Ultra-widefield (UWF) fundus image.
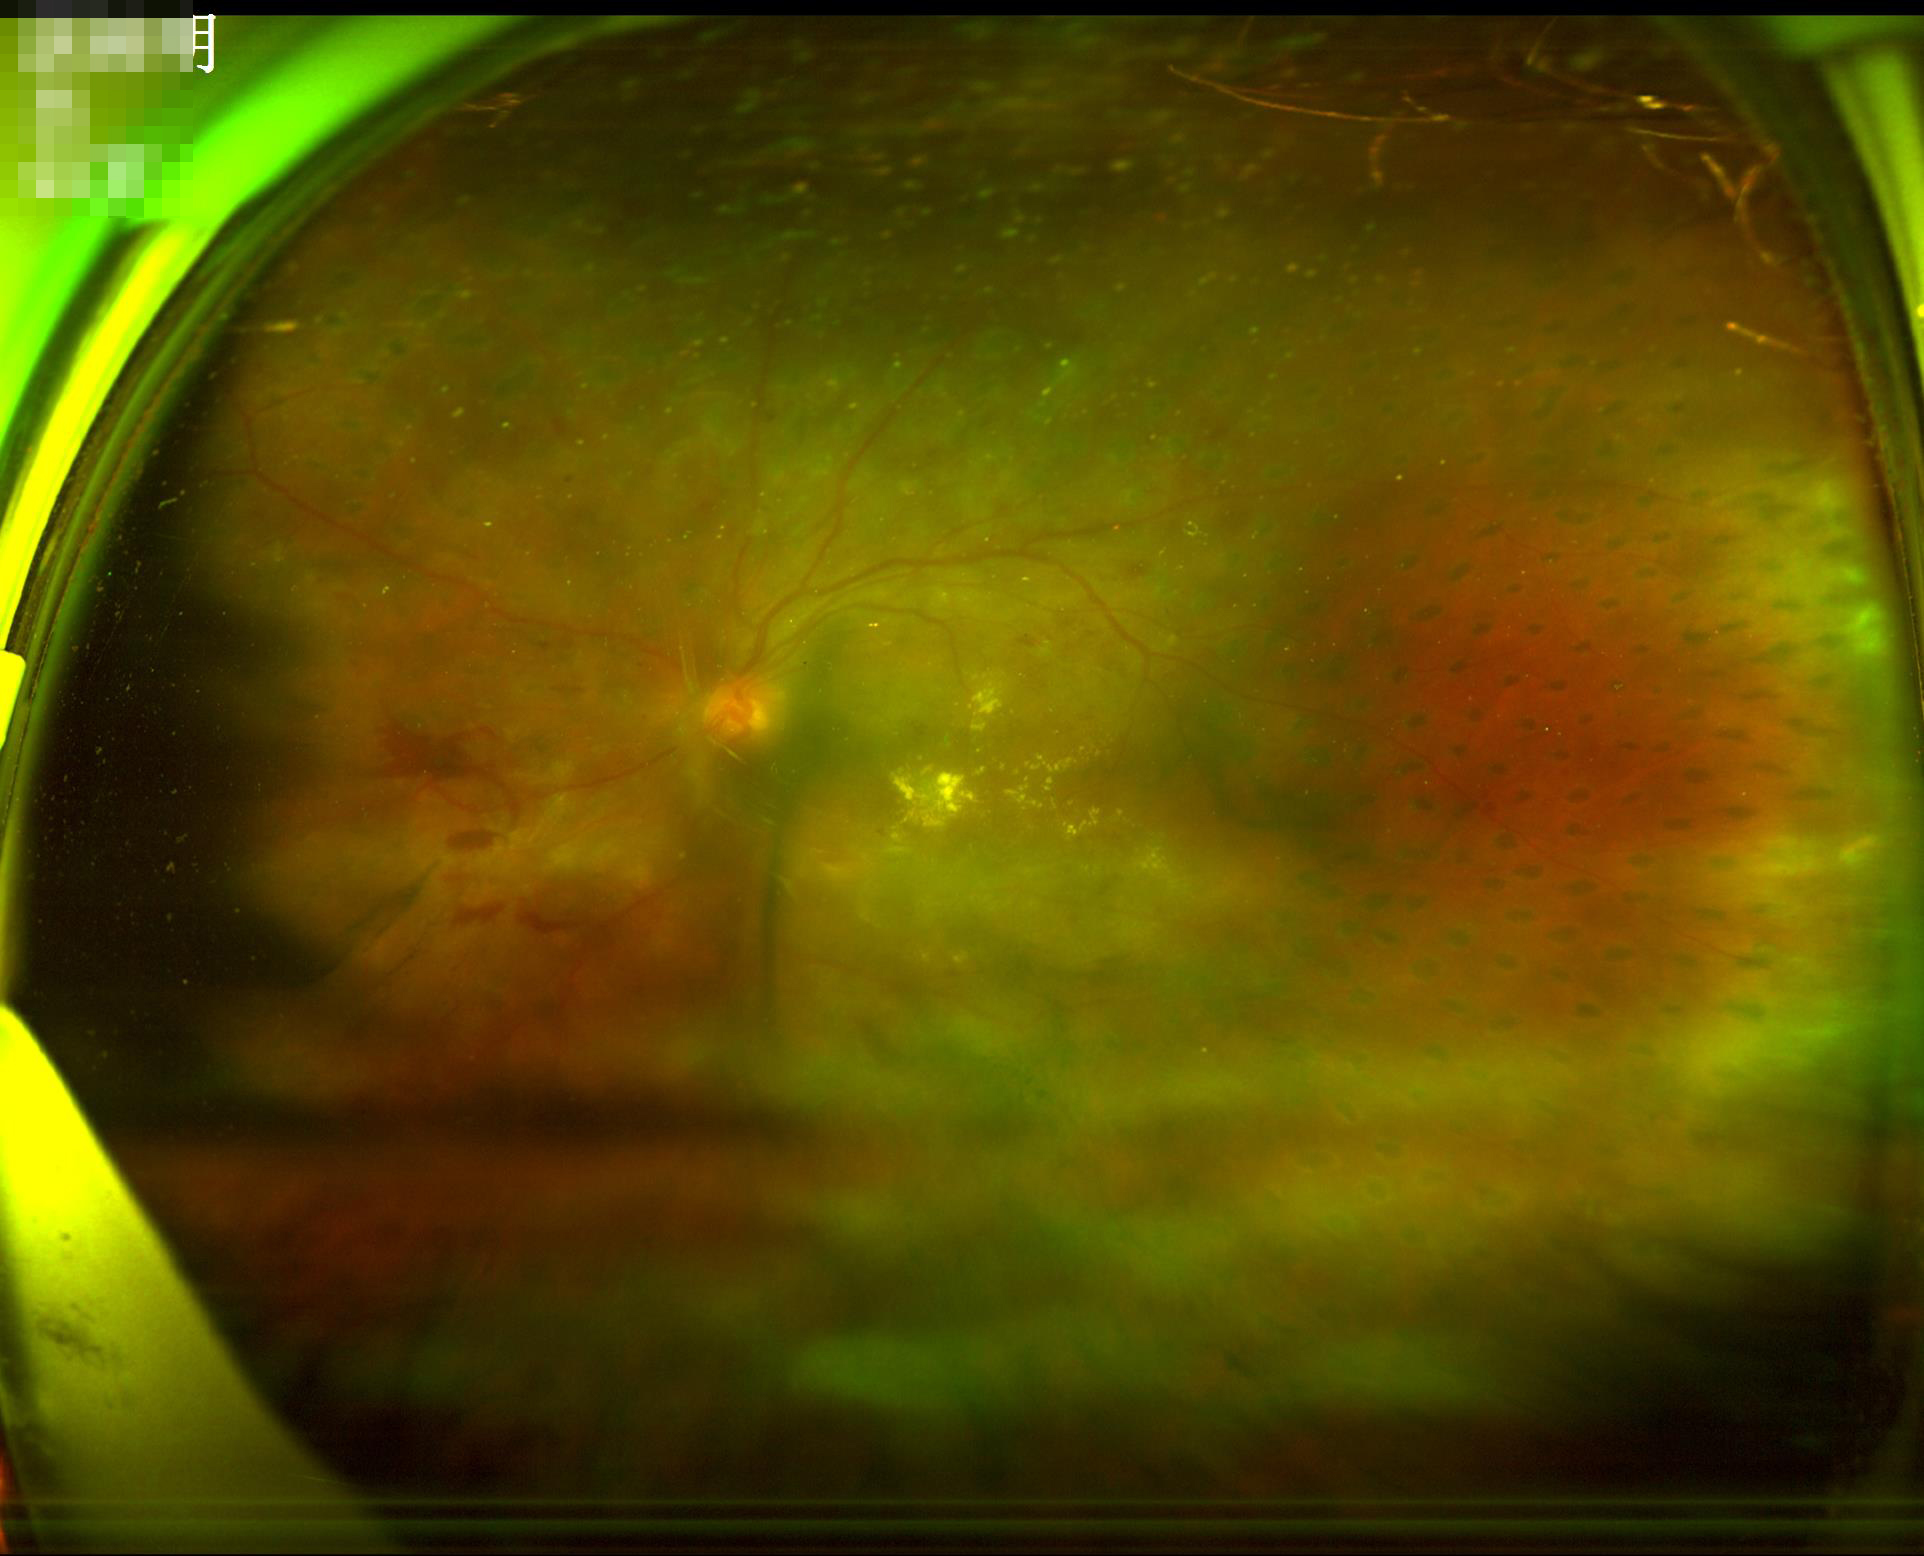

Illumination is uneven.
Out of focus; structures are indistinct.
Overall image quality is poor.
Contrast is good.